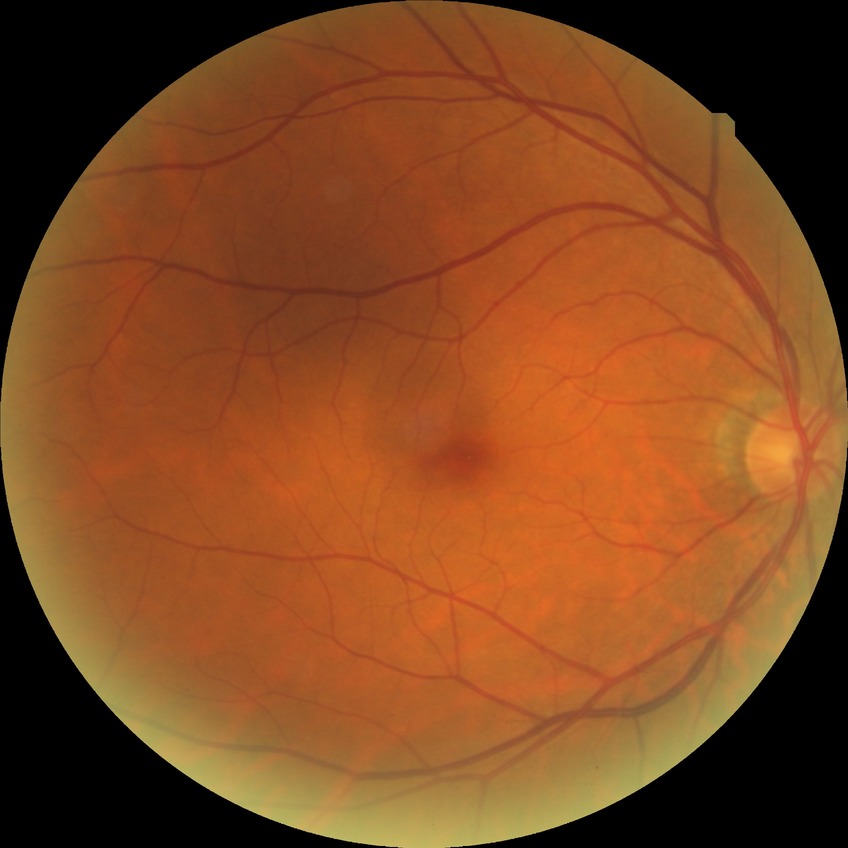

retinopathy stage = no diabetic retinopathy.